640 x 480 pixels; Clarity RetCam 3, 130° FOV; pediatric retinal photograph (wide-field).
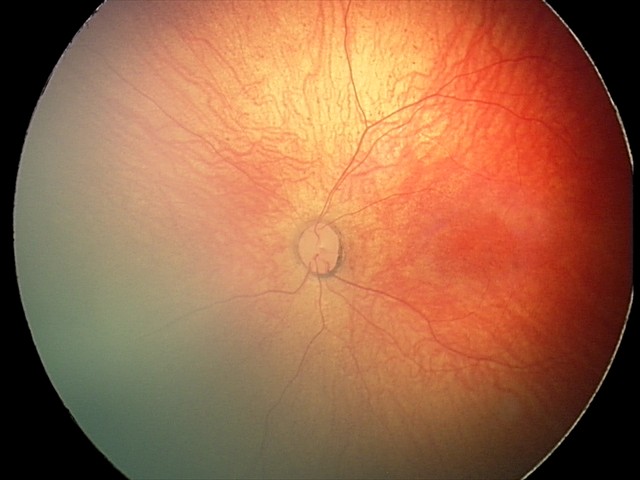

Examination with physiological retinal findings.